848 x 848 pixels: 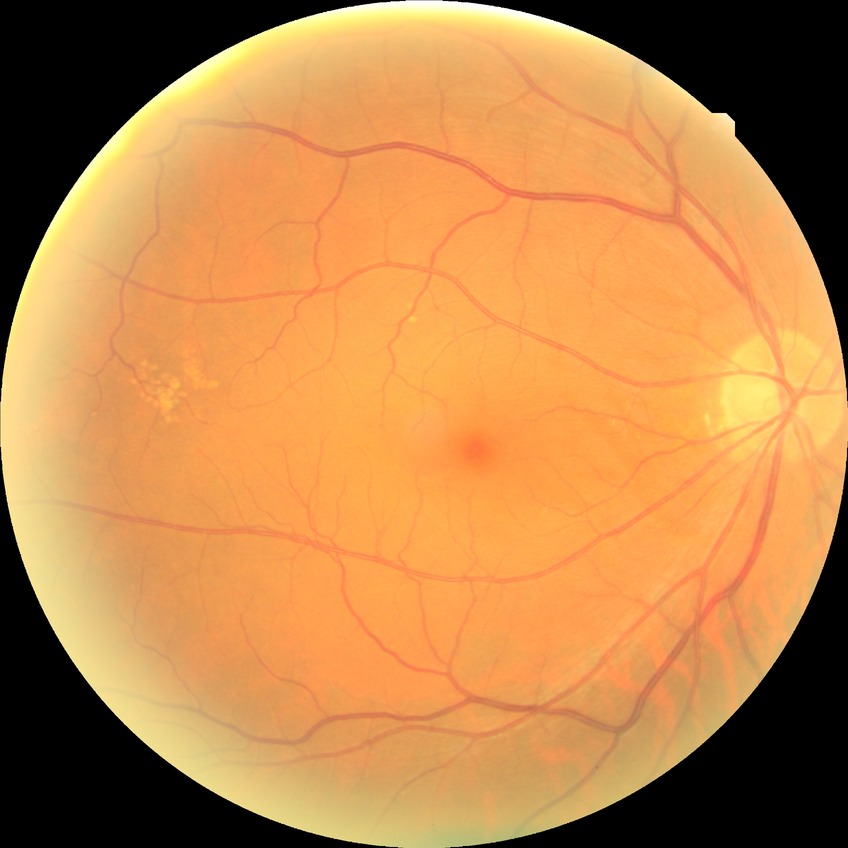

Diabetic retinopathy (DR) is no diabetic retinopathy (NDR).